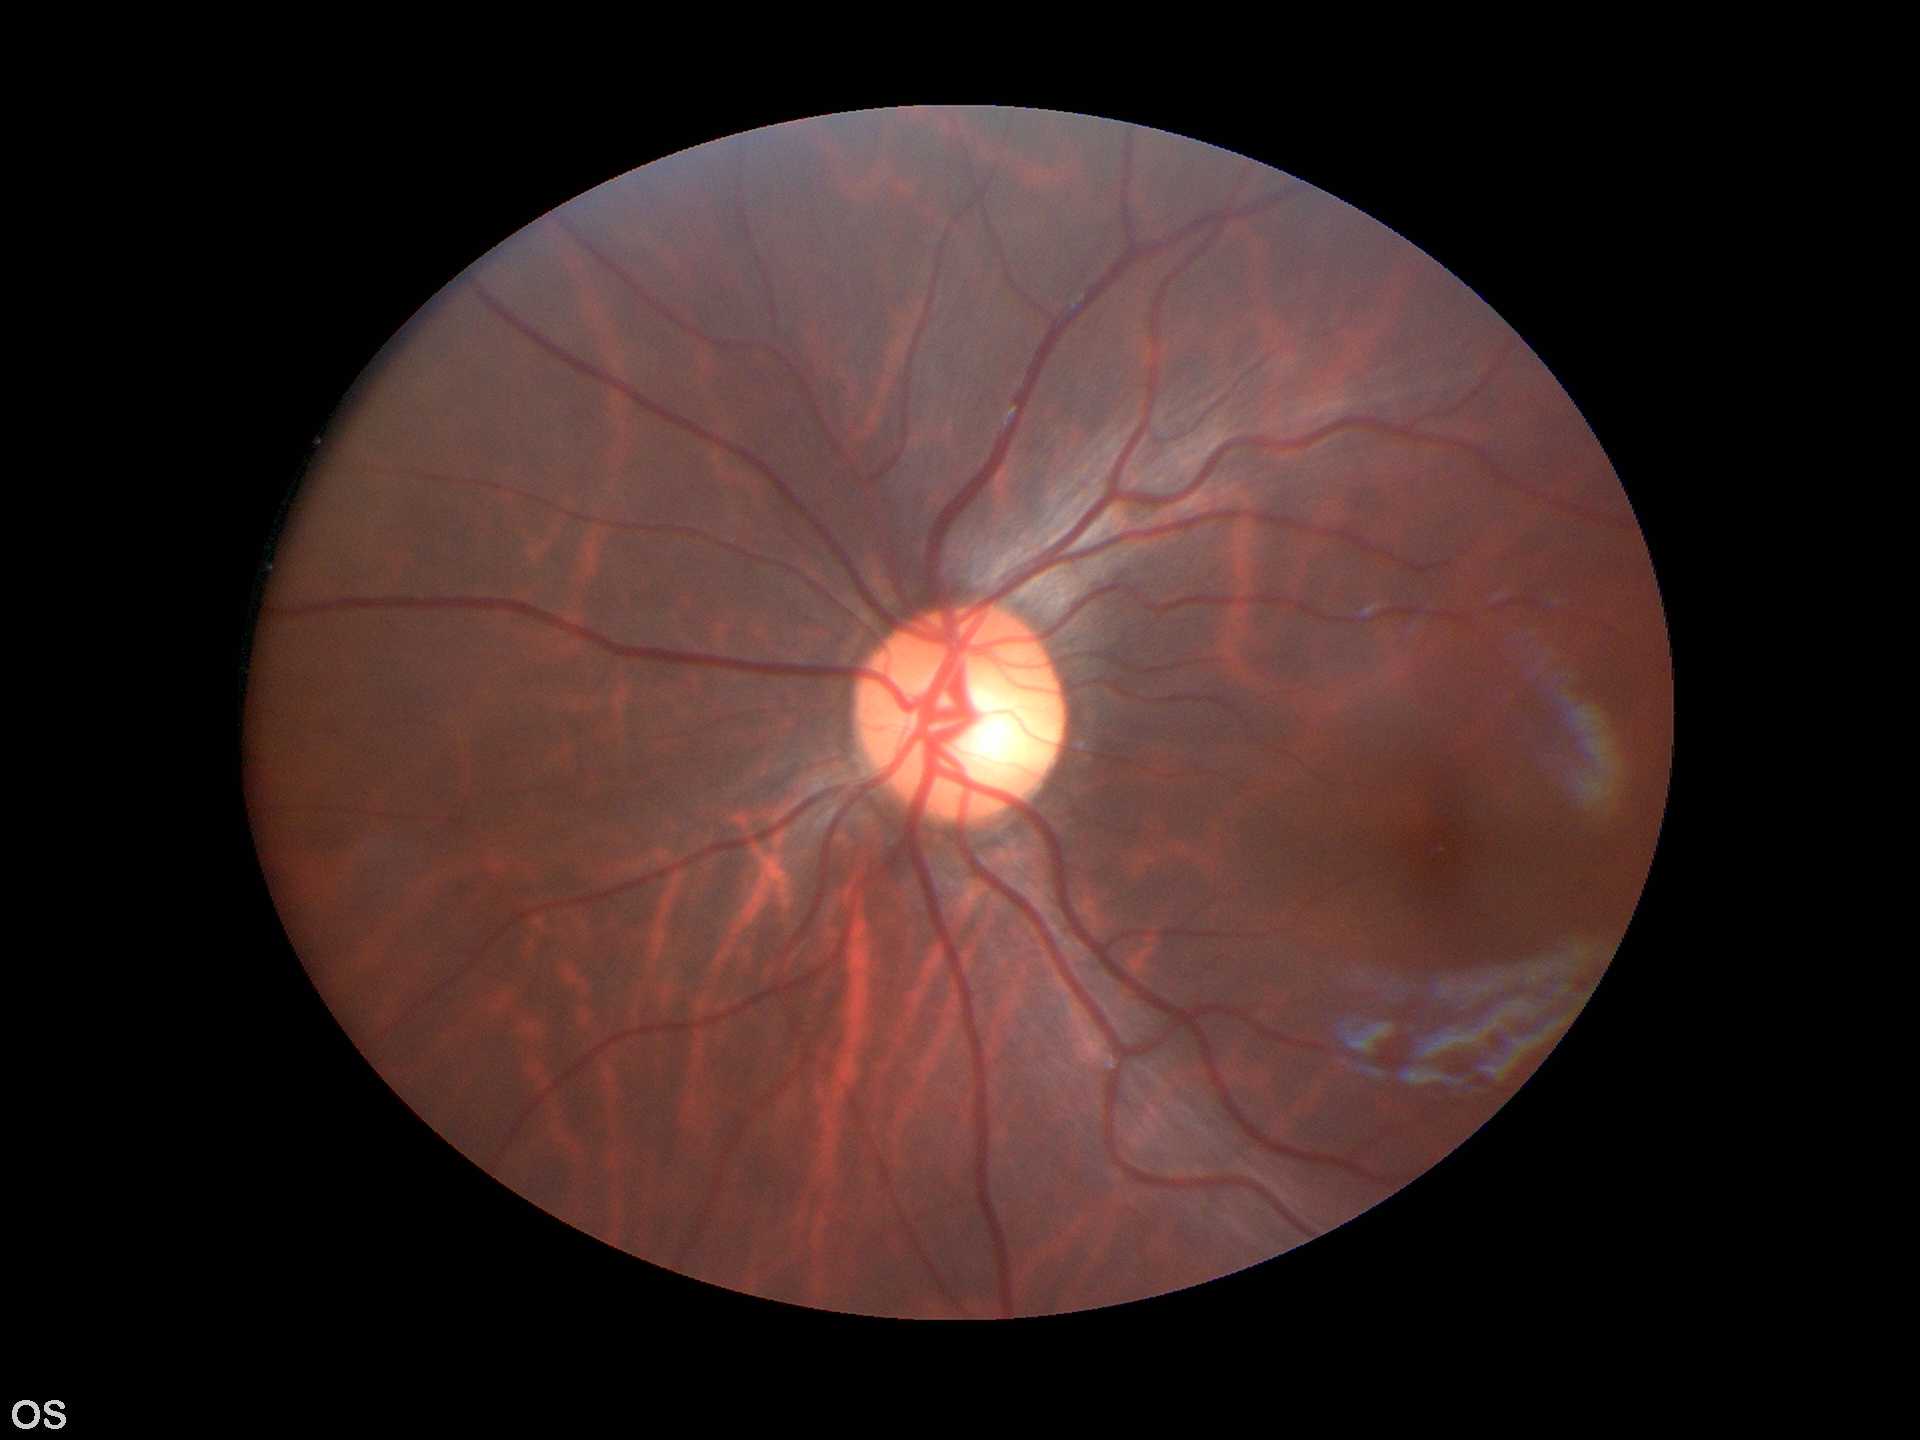 Not suspicious for glaucoma. Vertical CDR (VCDR): 0.55.